640 x 480 pixels. RetCam wide-field infant fundus image:
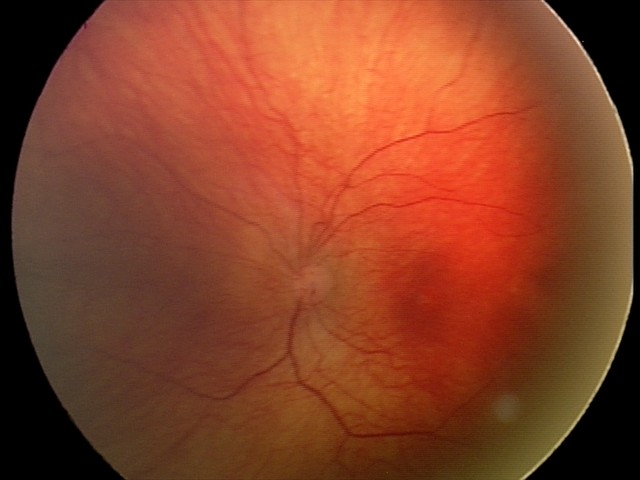 Examination diagnosed as status post retinopathy of prematurity (ROP).
No plus disease.